848x848 · graded on the modified Davis scale · 45° FOV:
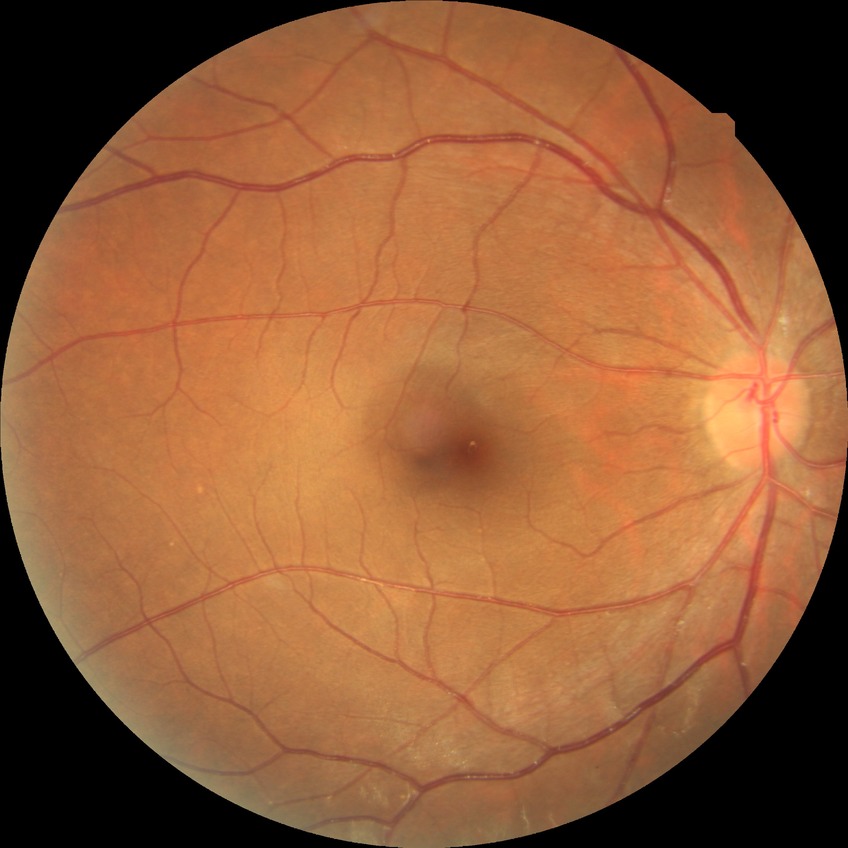

- diabetic retinopathy (DR): no diabetic retinopathy (NDR)